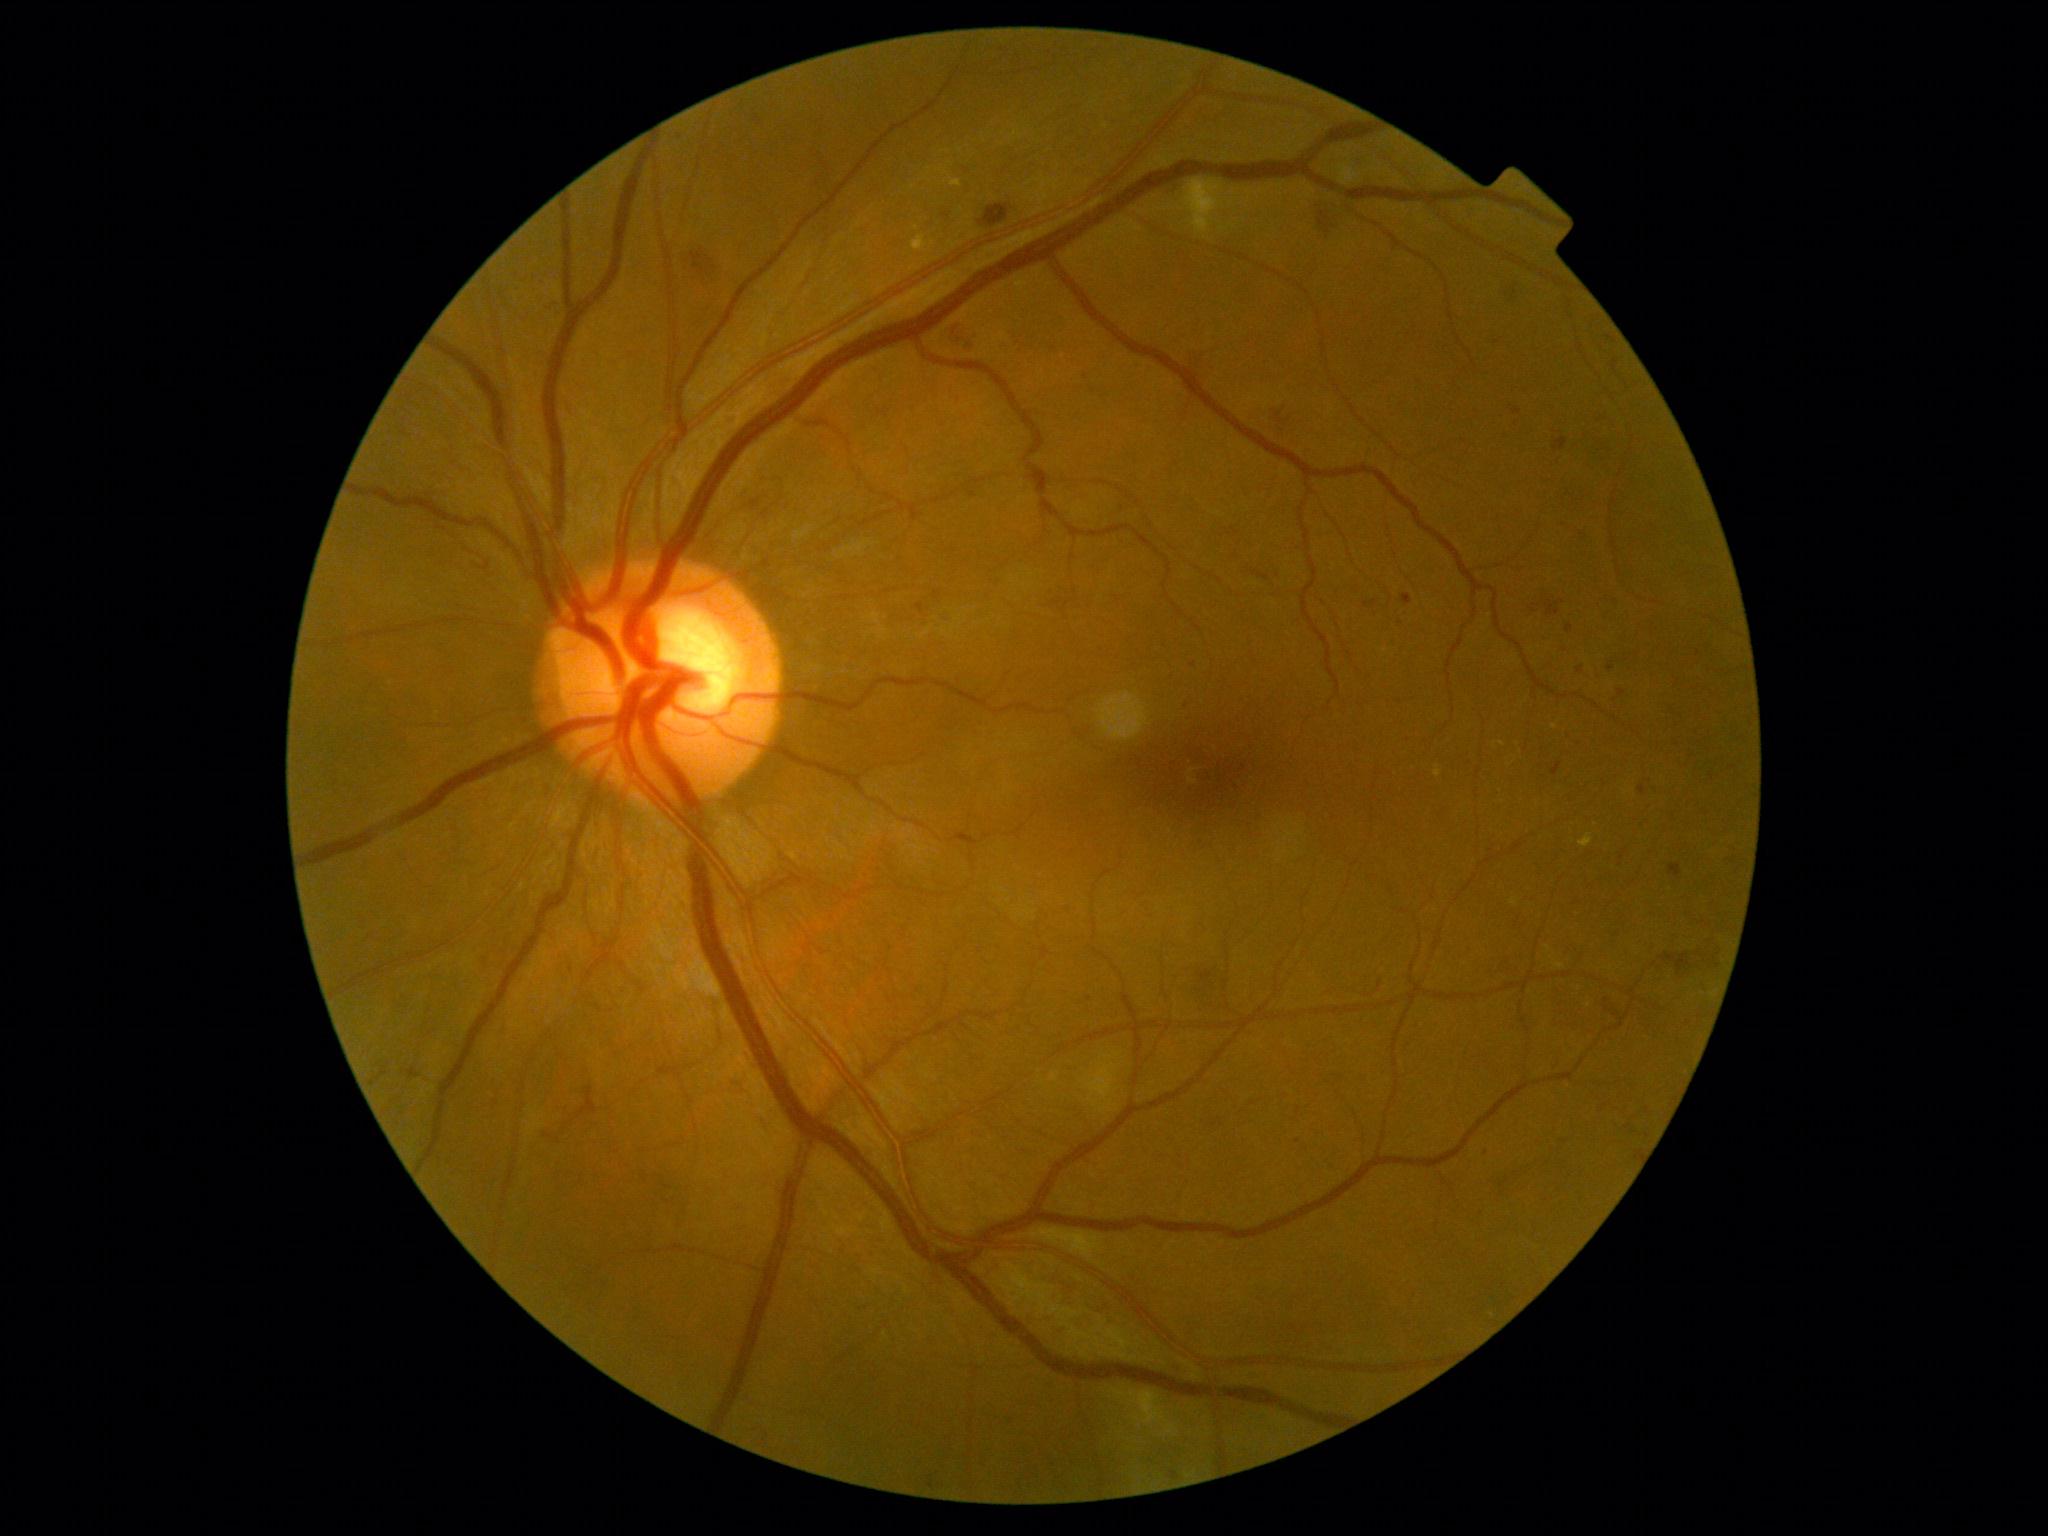
Retinopathy grade is moderate non-proliferative diabetic retinopathy (2)
A subset of detected lesions:
microaneurysms (partial) = x1=1171 y1=1471 x2=1178 y2=1479; x1=1636 y1=1150 x2=1644 y2=1160; x1=1614 y1=932 x2=1623 y2=938; x1=857 y1=1308 x2=867 y2=1316; x1=1553 y1=438 x2=1568 y2=452; x1=1564 y1=736 x2=1572 y2=748; x1=727 y1=413 x2=736 y2=423; x1=1552 y1=762 x2=1562 y2=777; x1=1402 y1=593 x2=1413 y2=605; x1=1334 y1=1075 x2=1341 y2=1085; x1=1513 y1=408 x2=1522 y2=415
Smaller microaneurysms around (x=1569, y=493); (x=1298, y=1142); (x=1648, y=1110)